Color fundus image; 848 x 848 pixels:
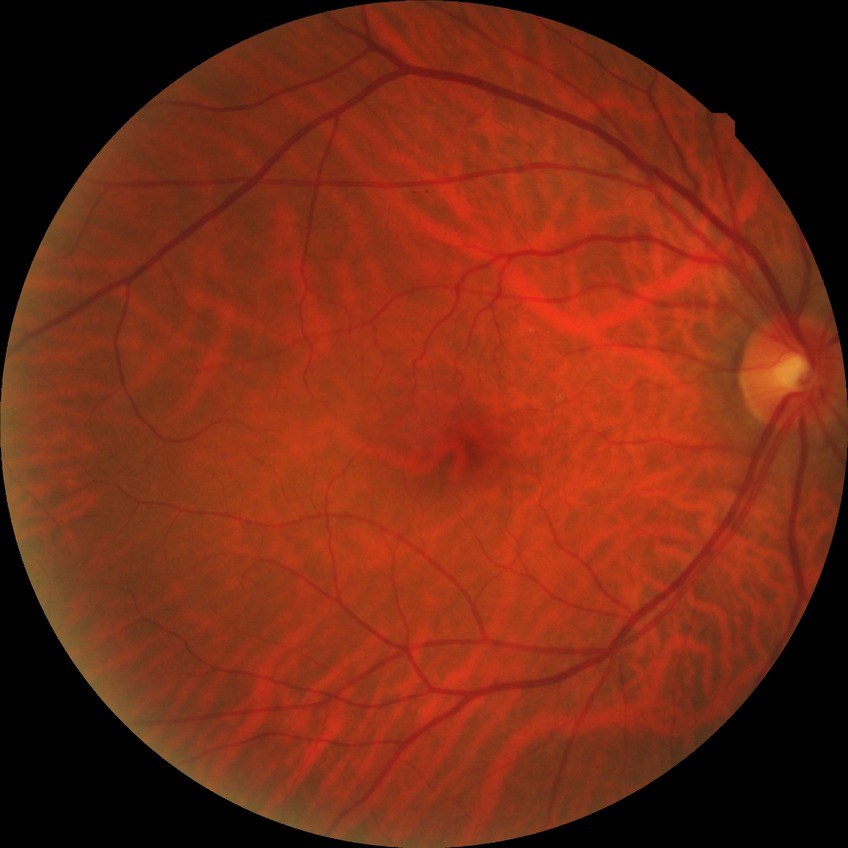

diabetic retinopathy grade = no diabetic retinopathy